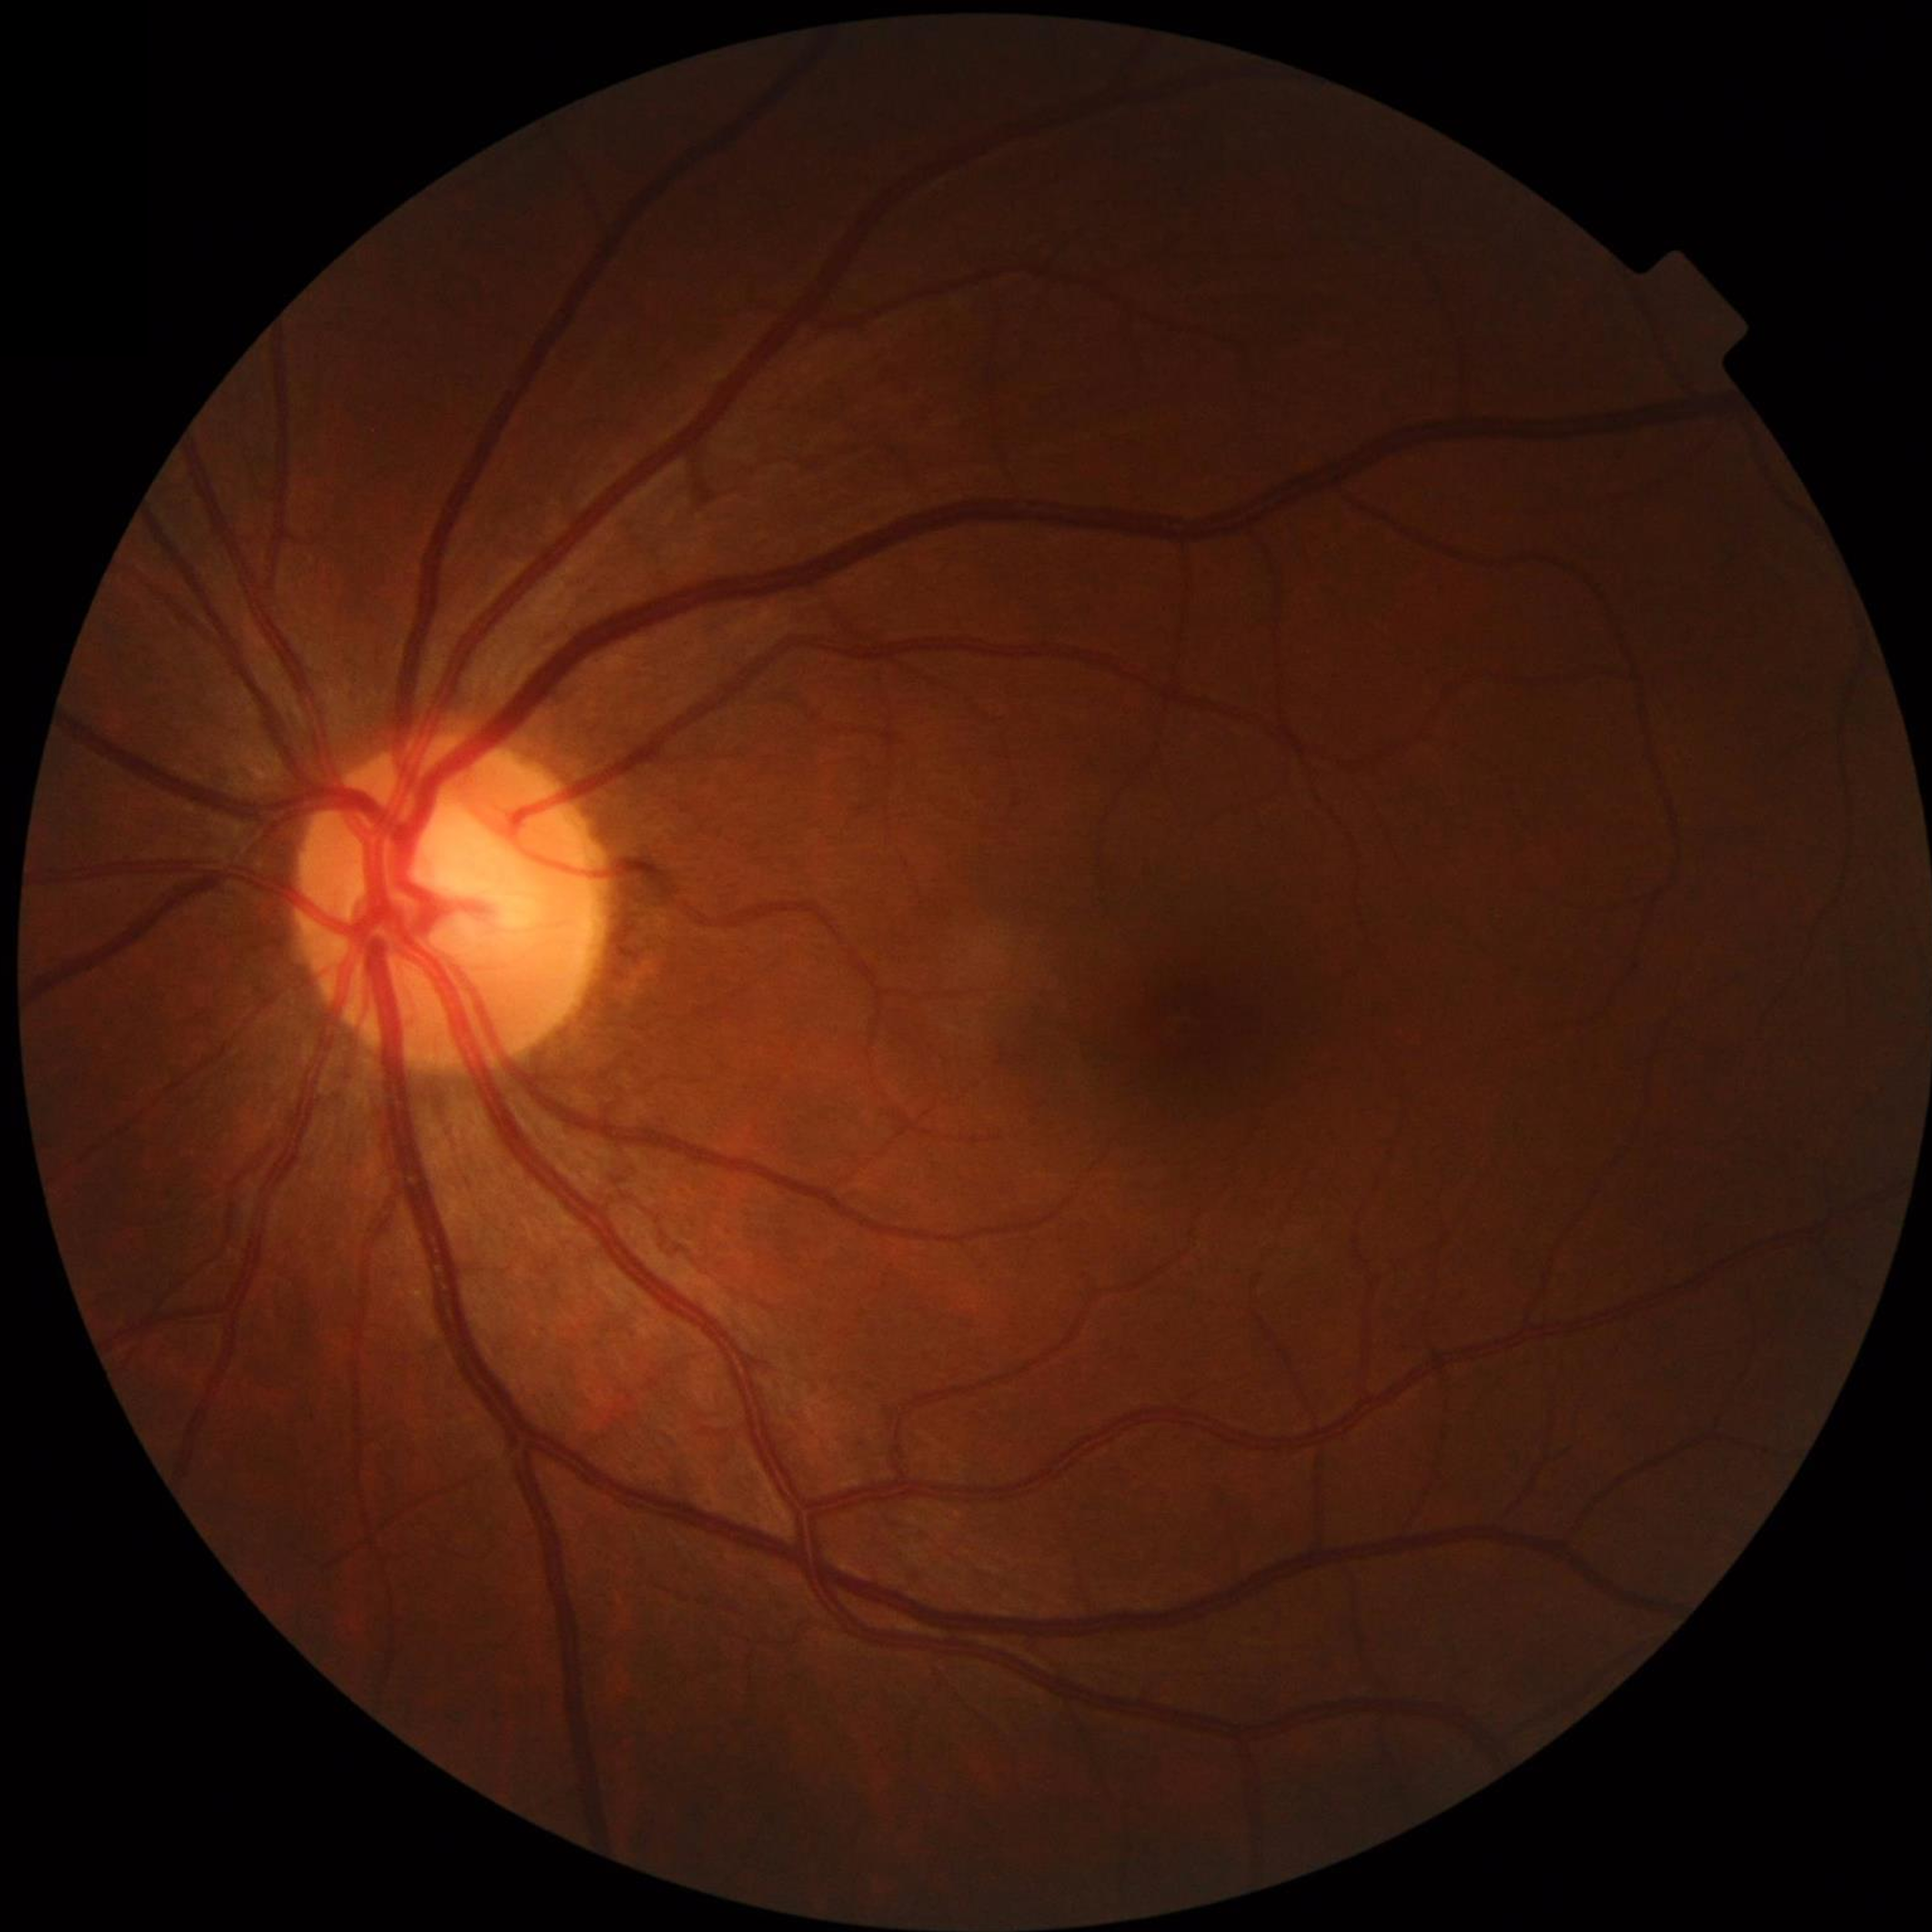 No findings of AMD, diabetic retinopathy, or glaucoma.